CFP — 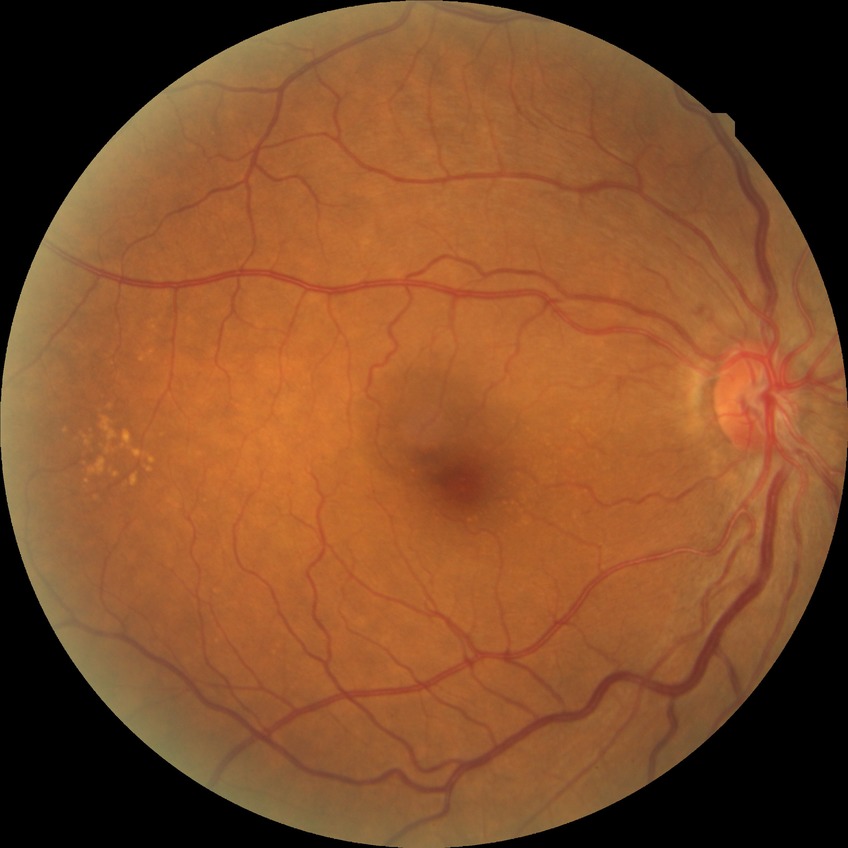
diabetic retinopathy grade@no diabetic retinopathy.